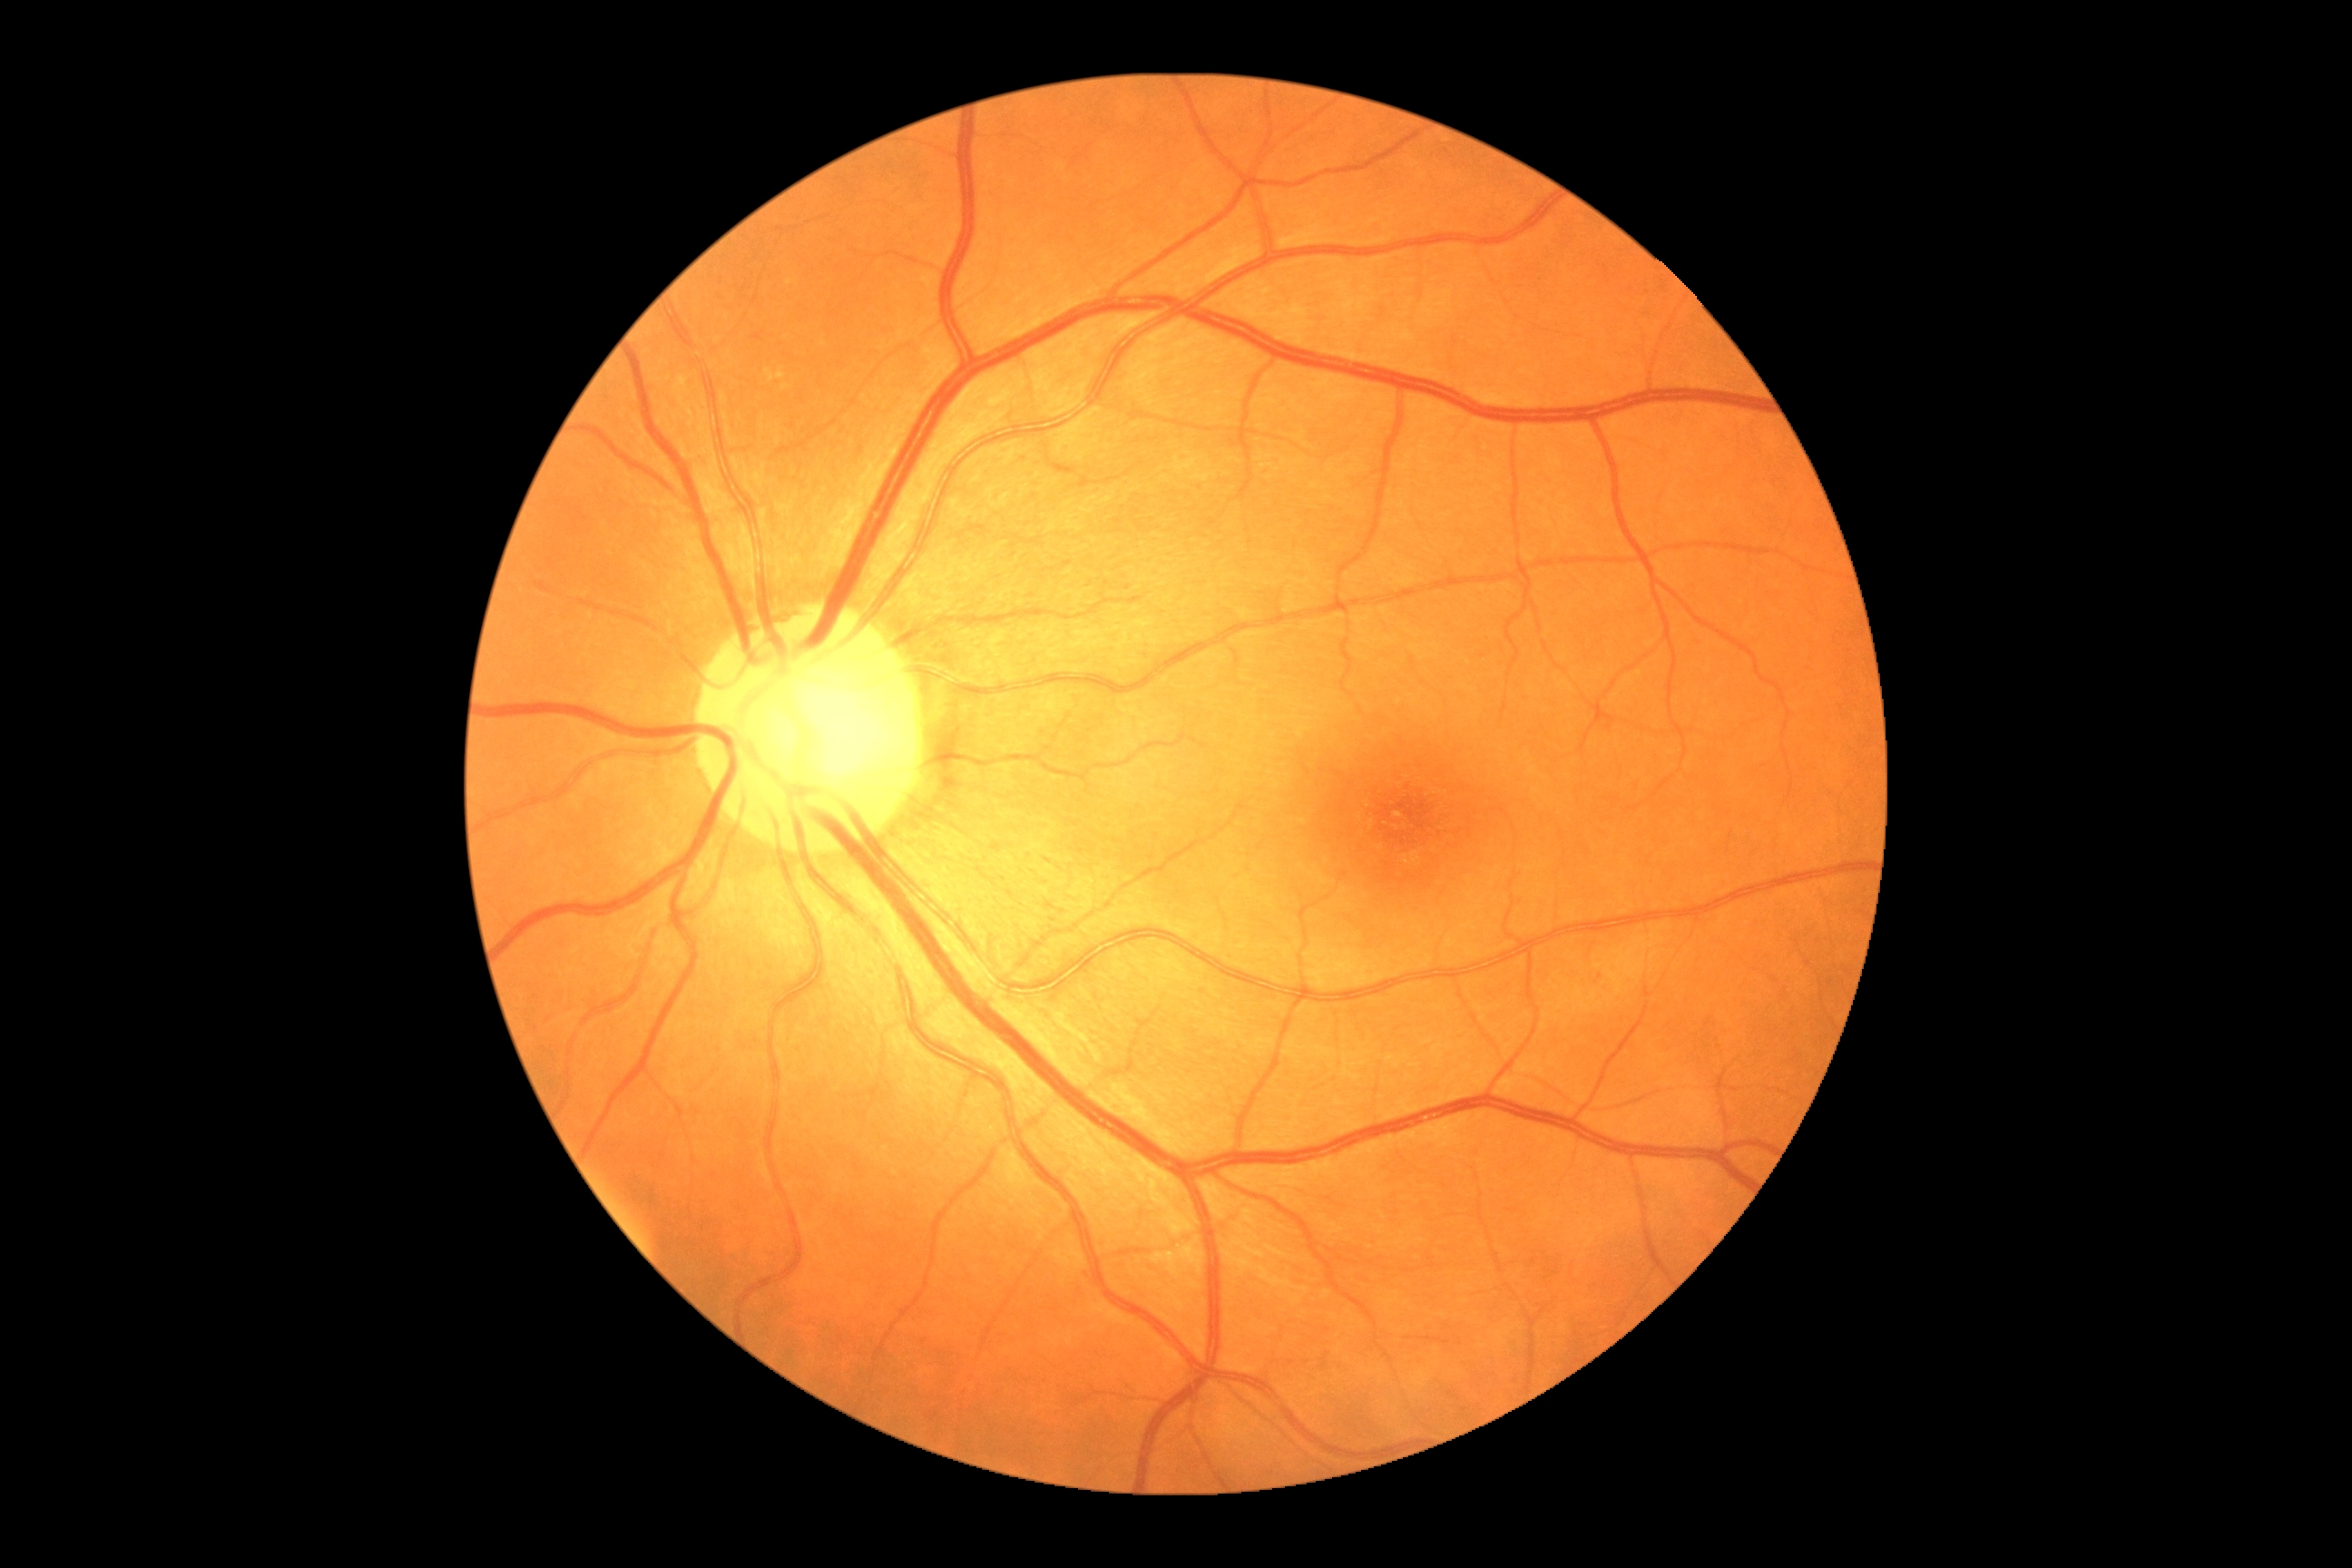 retinopathy=no apparent retinopathy (grade 0) — no visible signs of diabetic retinopathy.